1240 x 1240 pixels · wide-field fundus photograph of an infant.
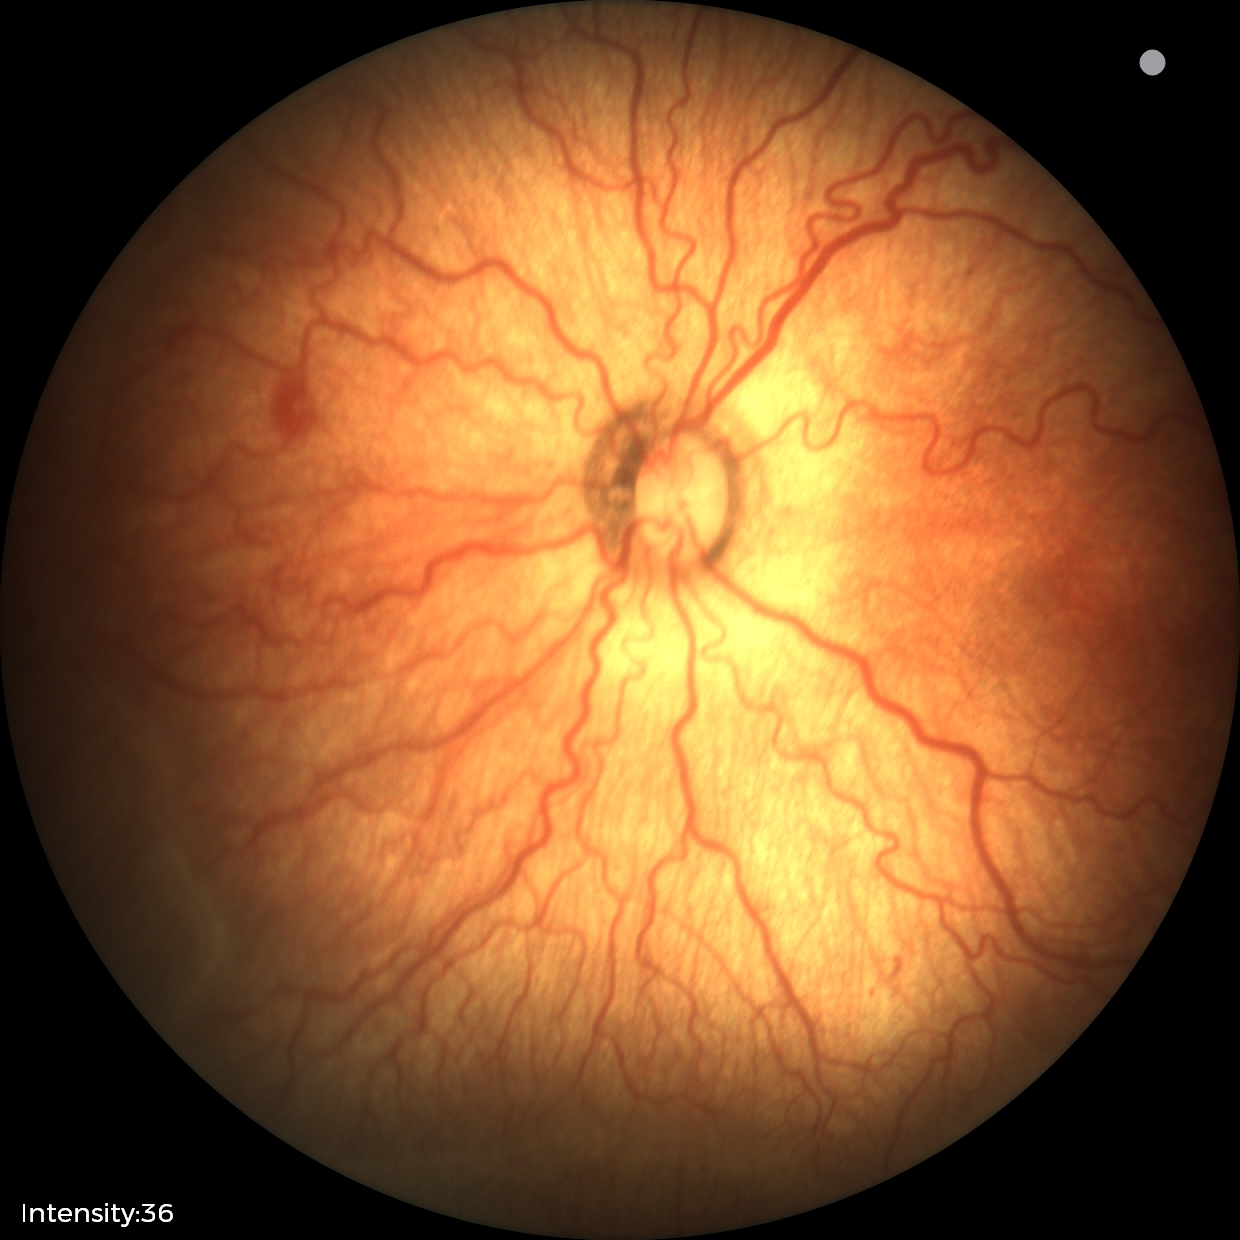
From an examination with diagnosis of ROP stage 2 — ridge with height and width at the demarcation line. With plus disease.